640x480px; wide-field fundus photograph from neonatal ROP screening; camera: Clarity RetCam 3 (130° FOV) — 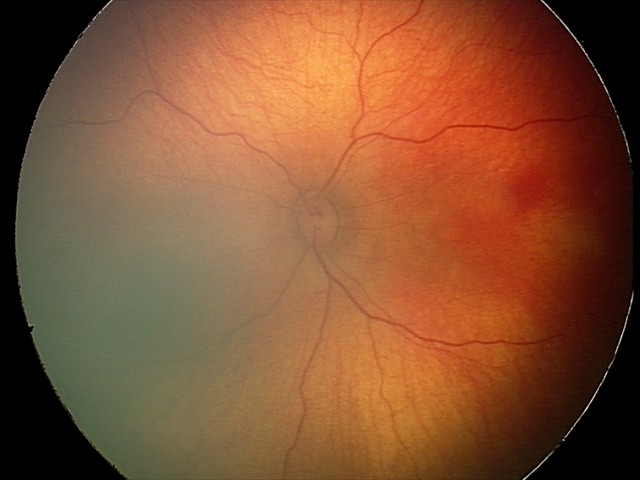
Assessment: no abnormal retinal findings.